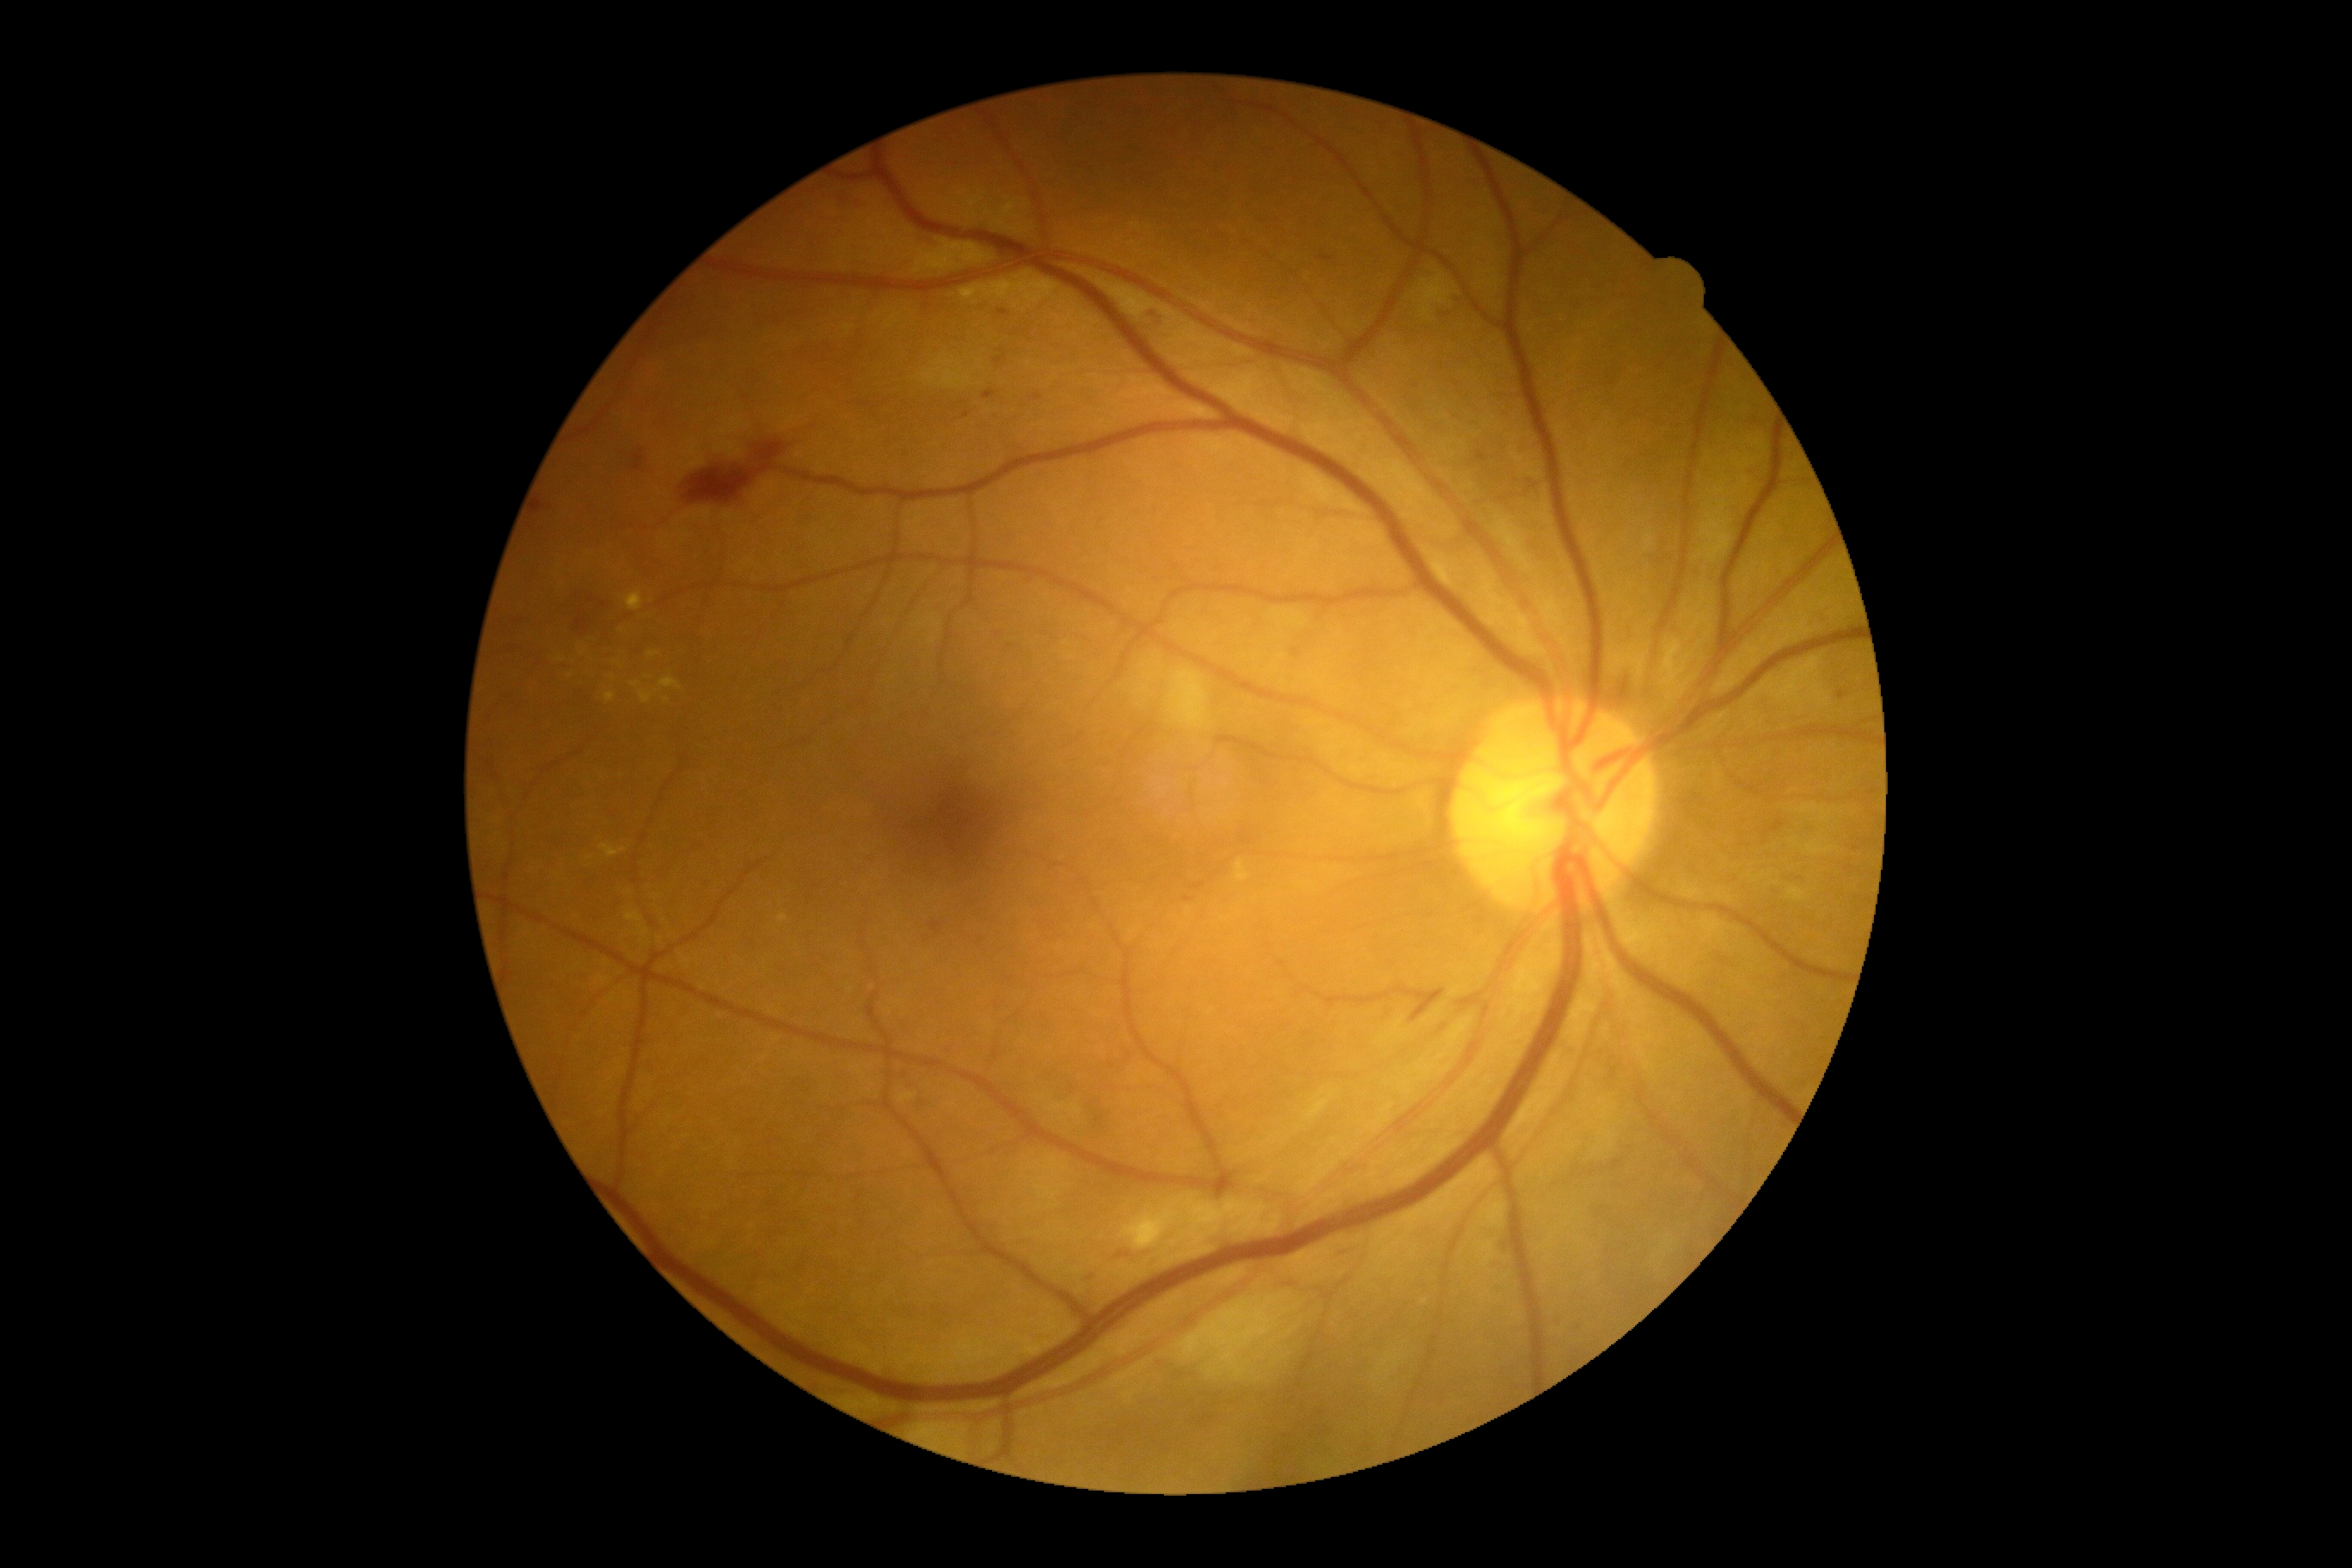
DR class = non-proliferative diabetic retinopathy
diabetic retinopathy = grade 2 (moderate NPDR)